45° field of view. 2352 by 1568 pixels. CFP.
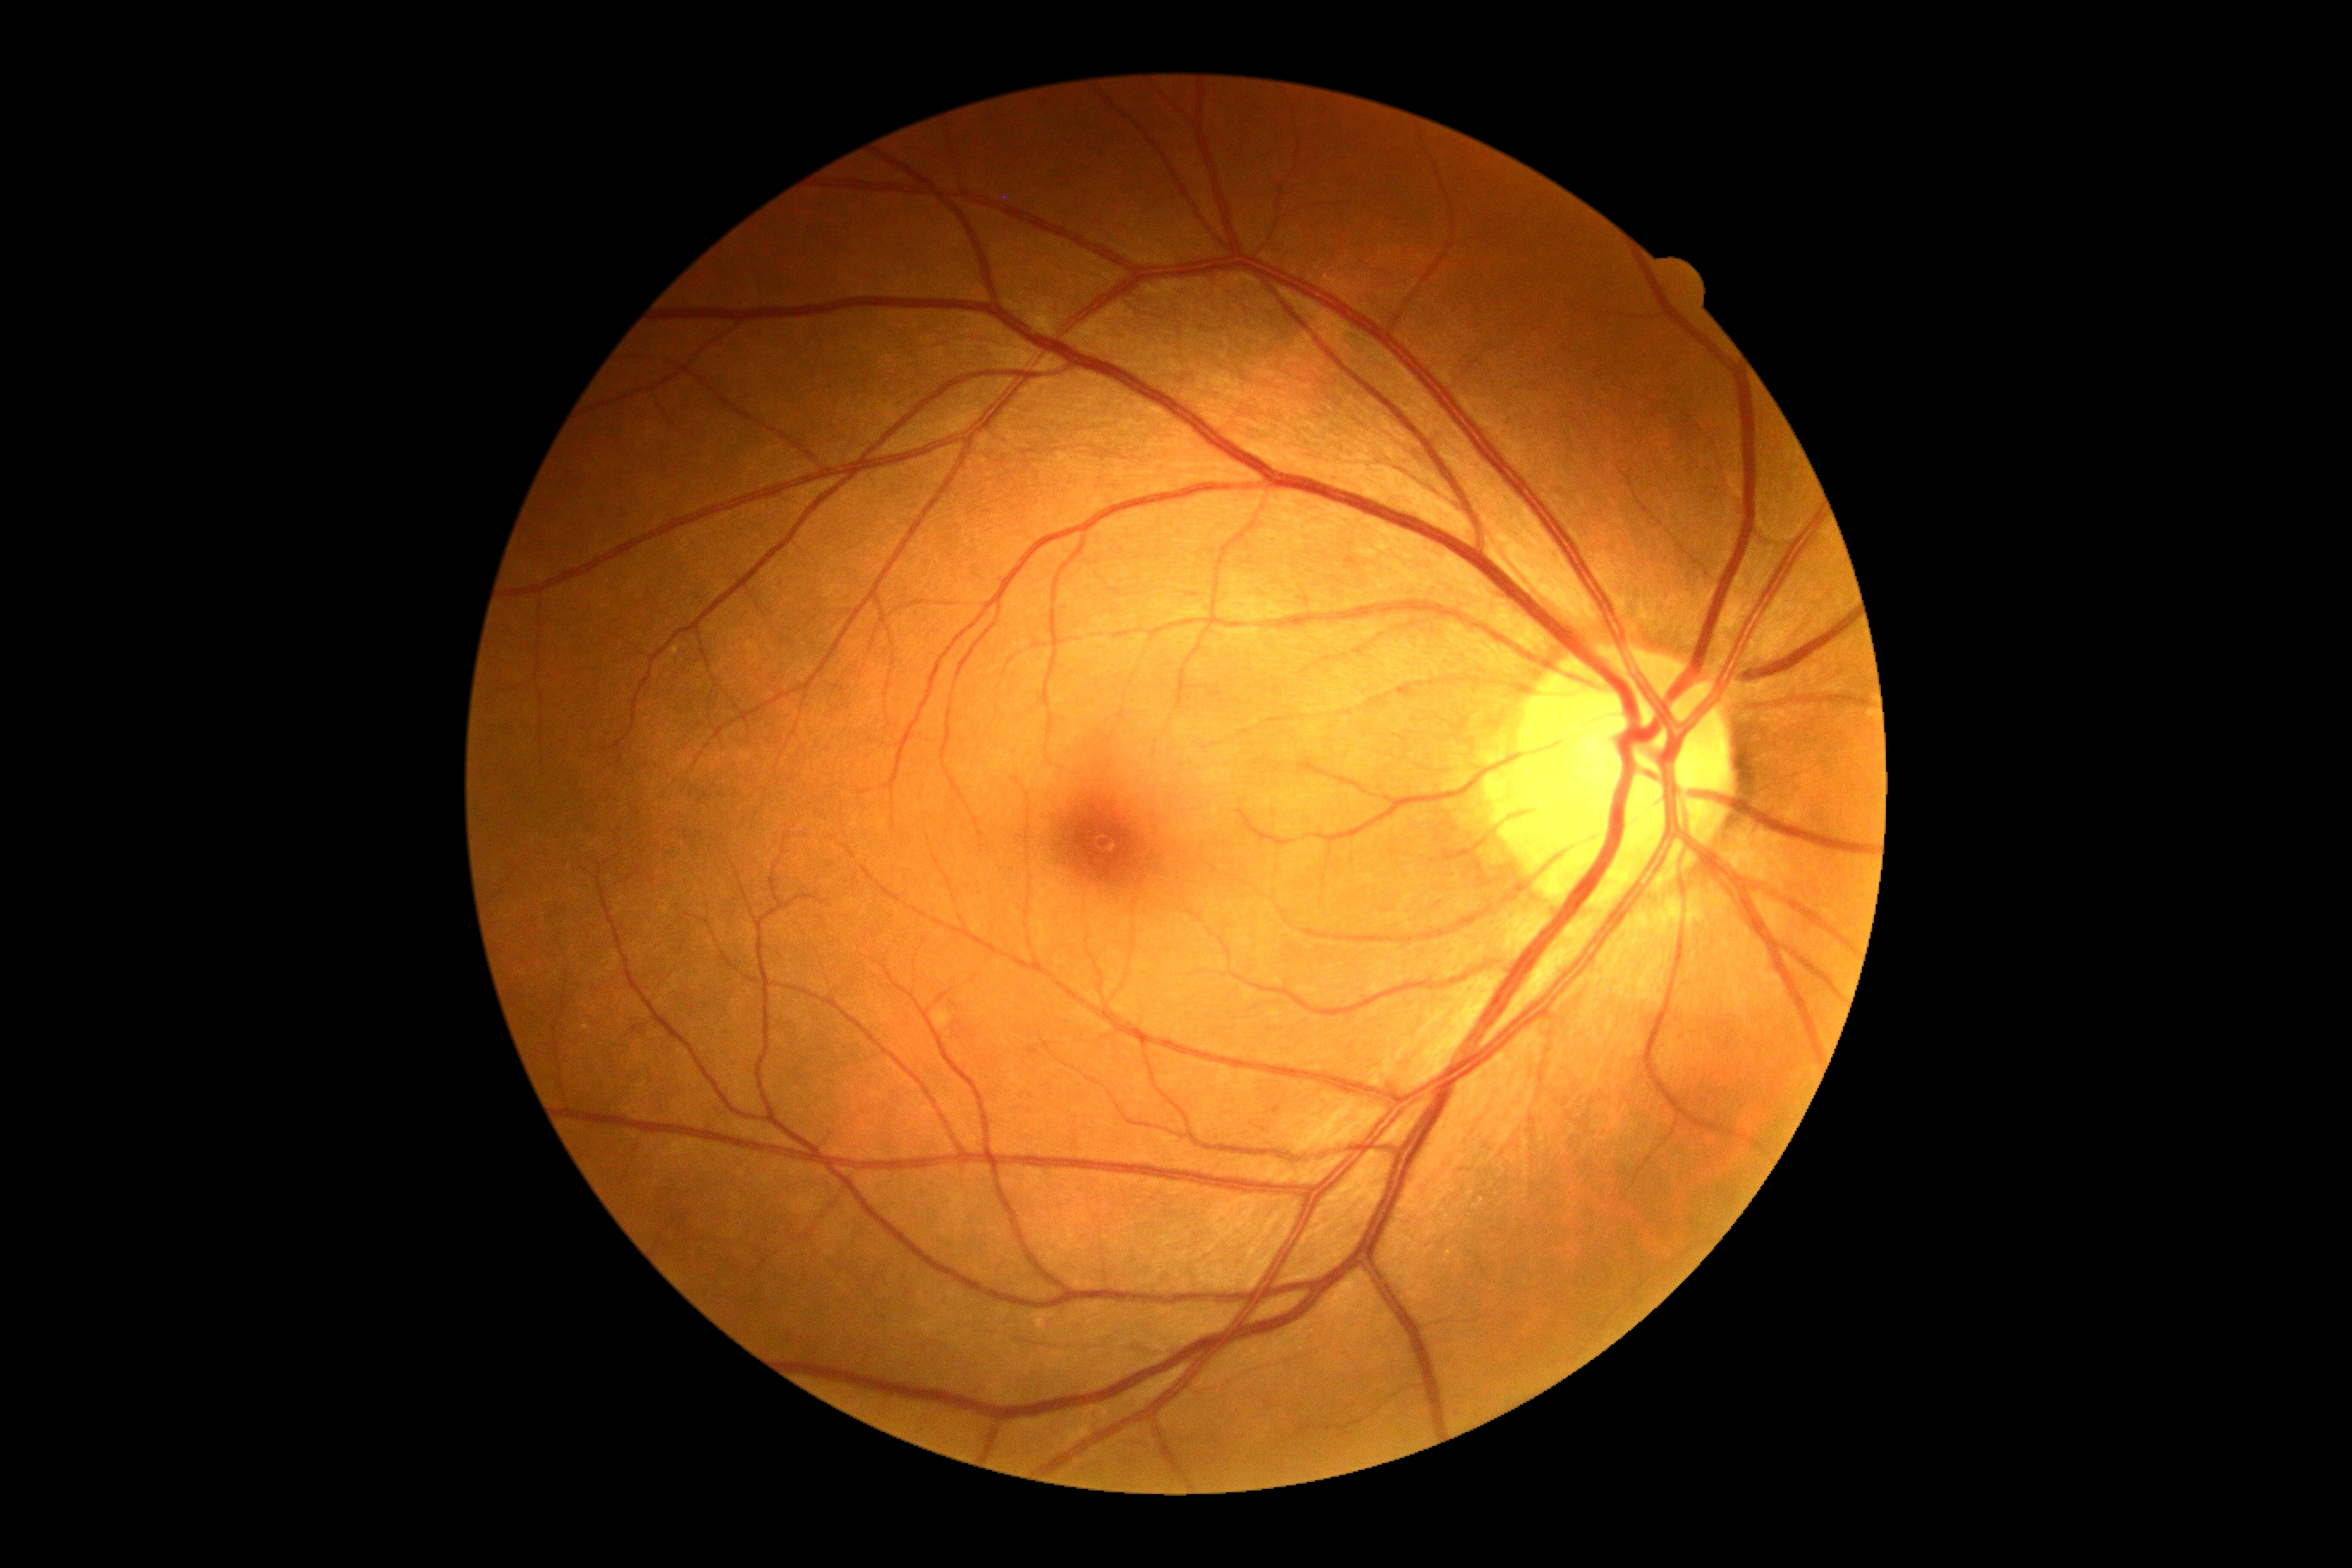 DR: 0.